2212 x 1659 pixels; FOV: 45 degrees; fundus photo:
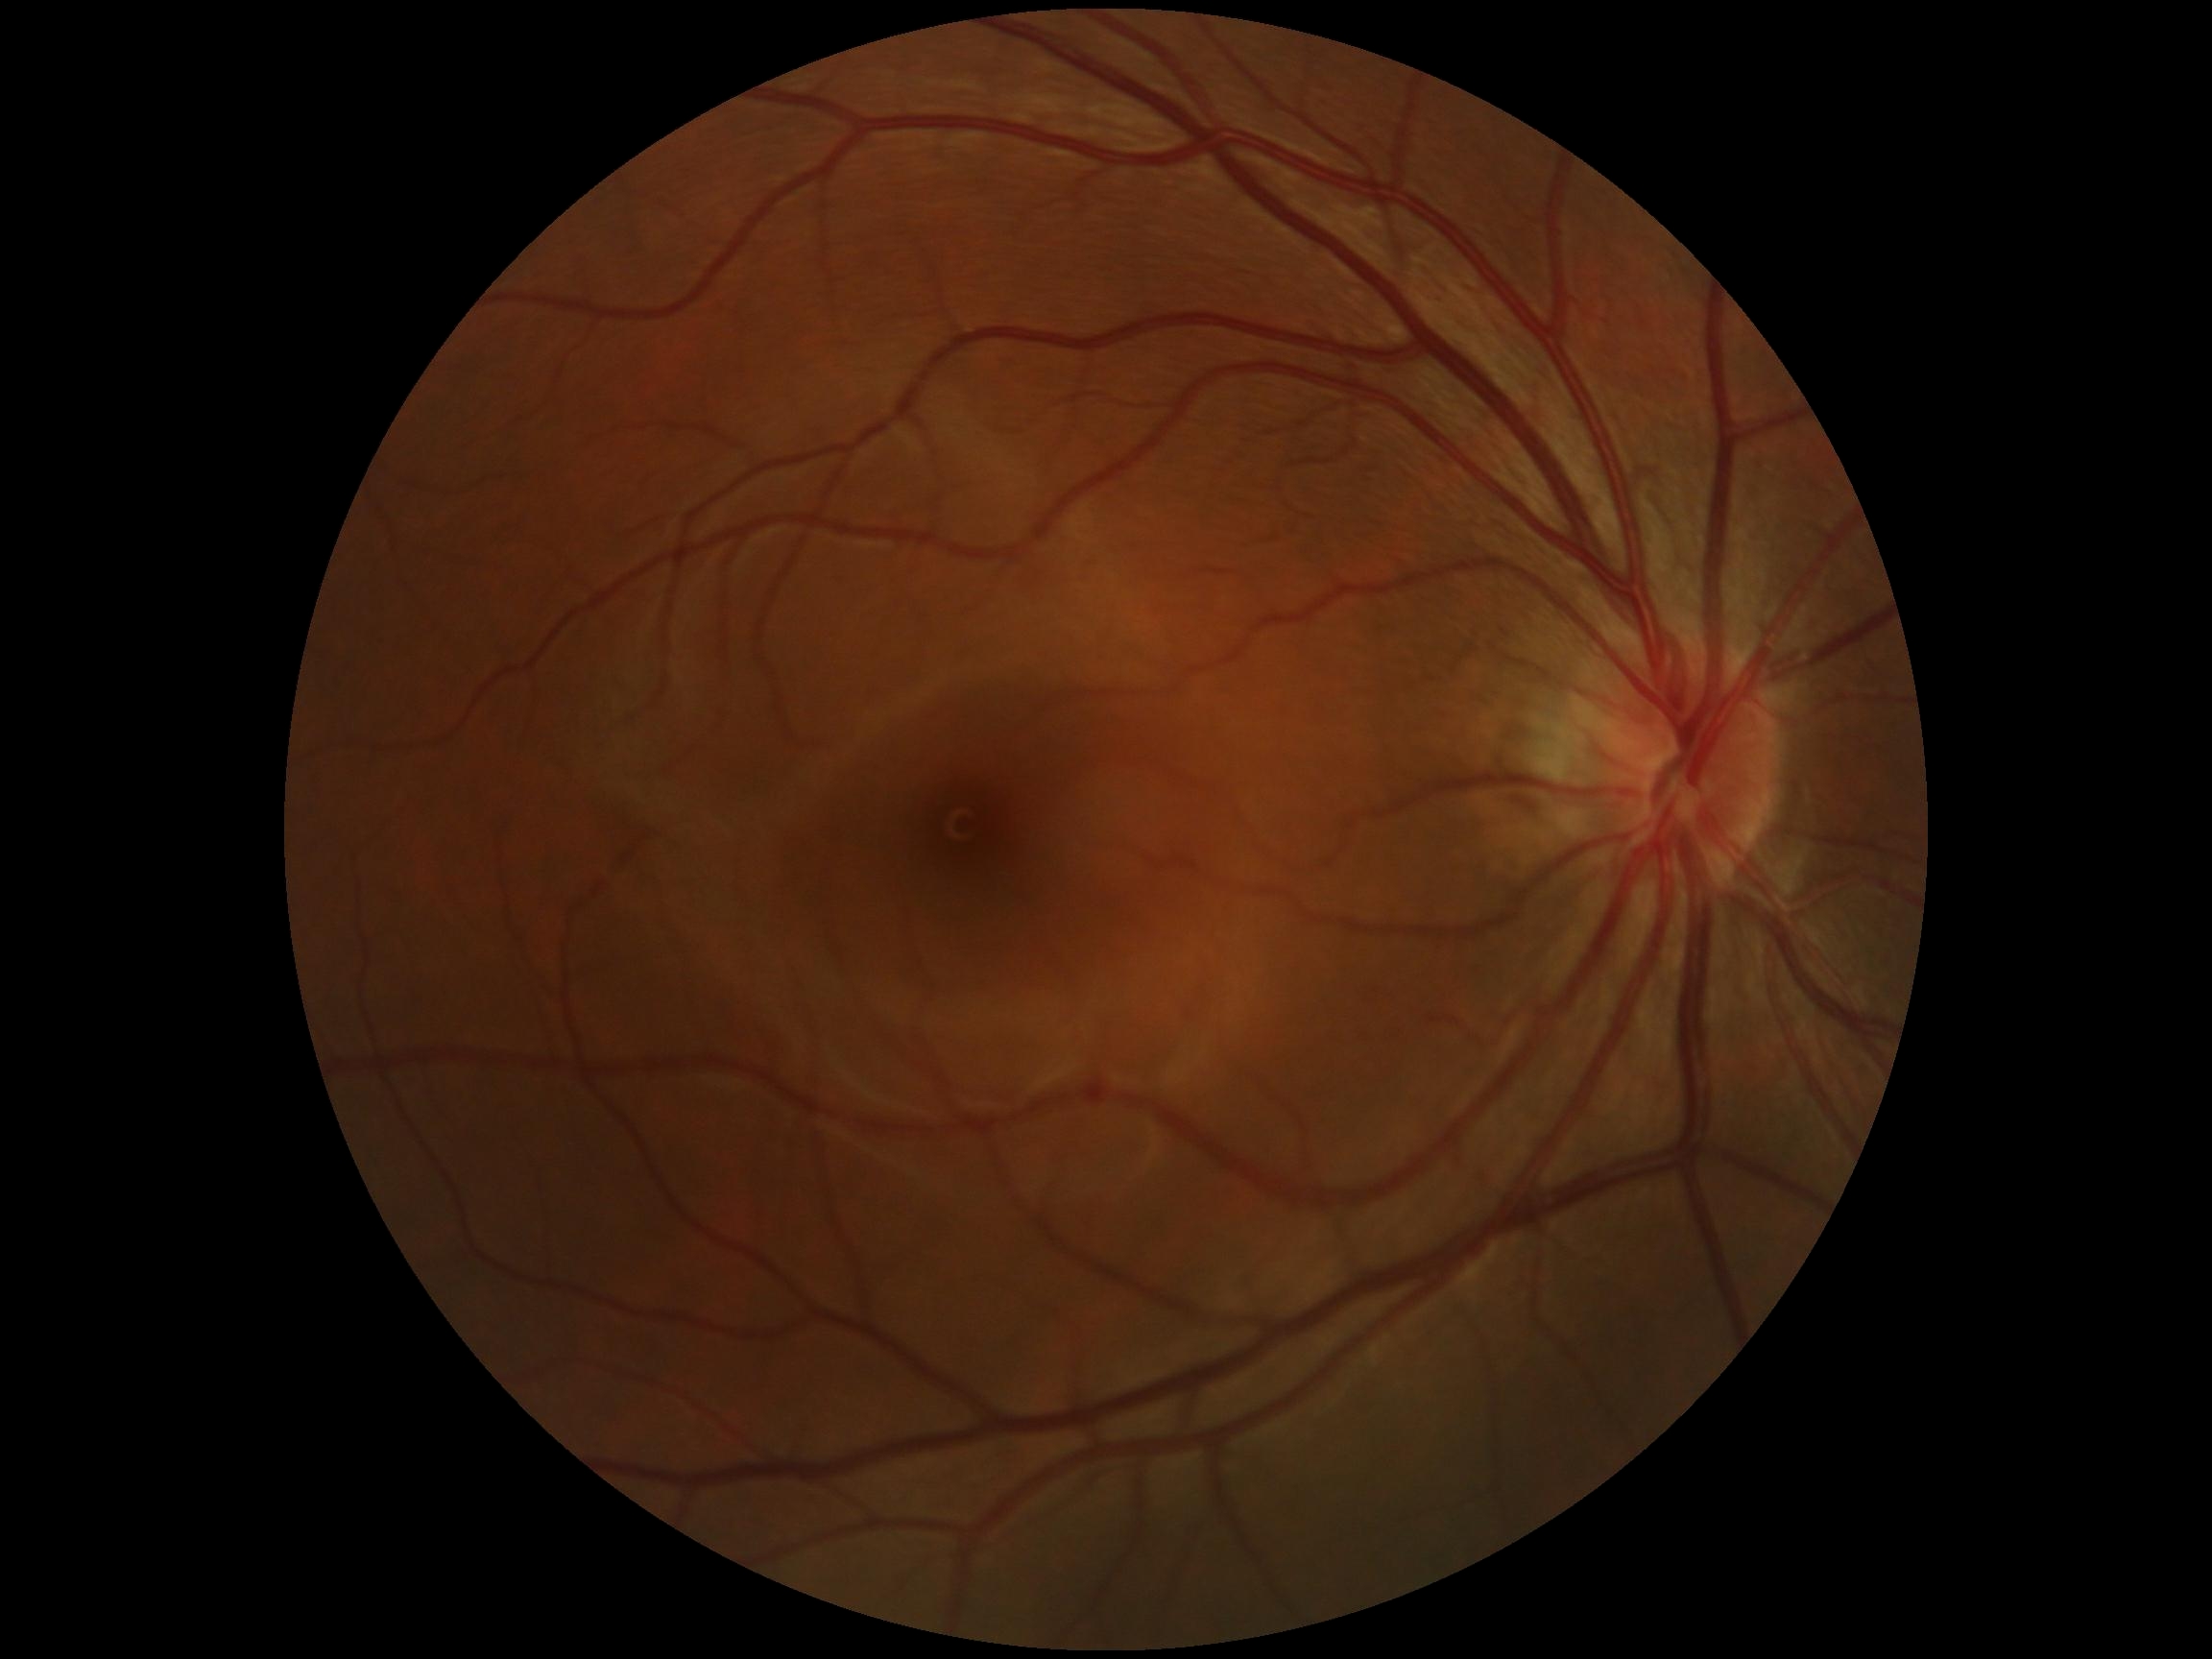

{"dr_grade": "grade 0 (no apparent retinopathy)"}